Nonmydriatic.
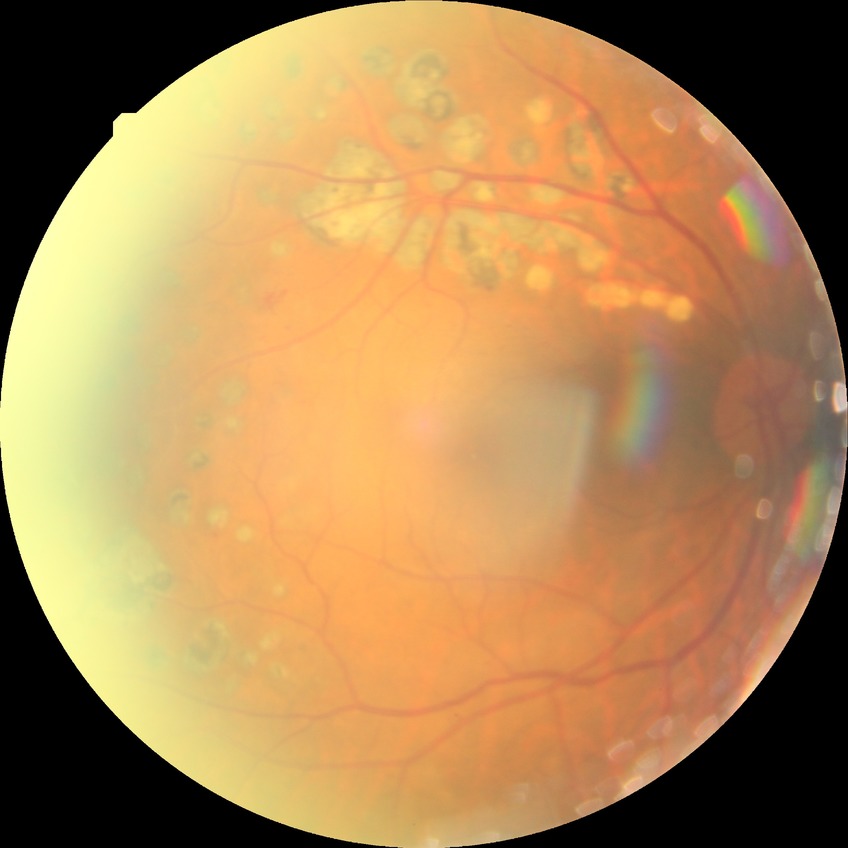
DR is PDR.